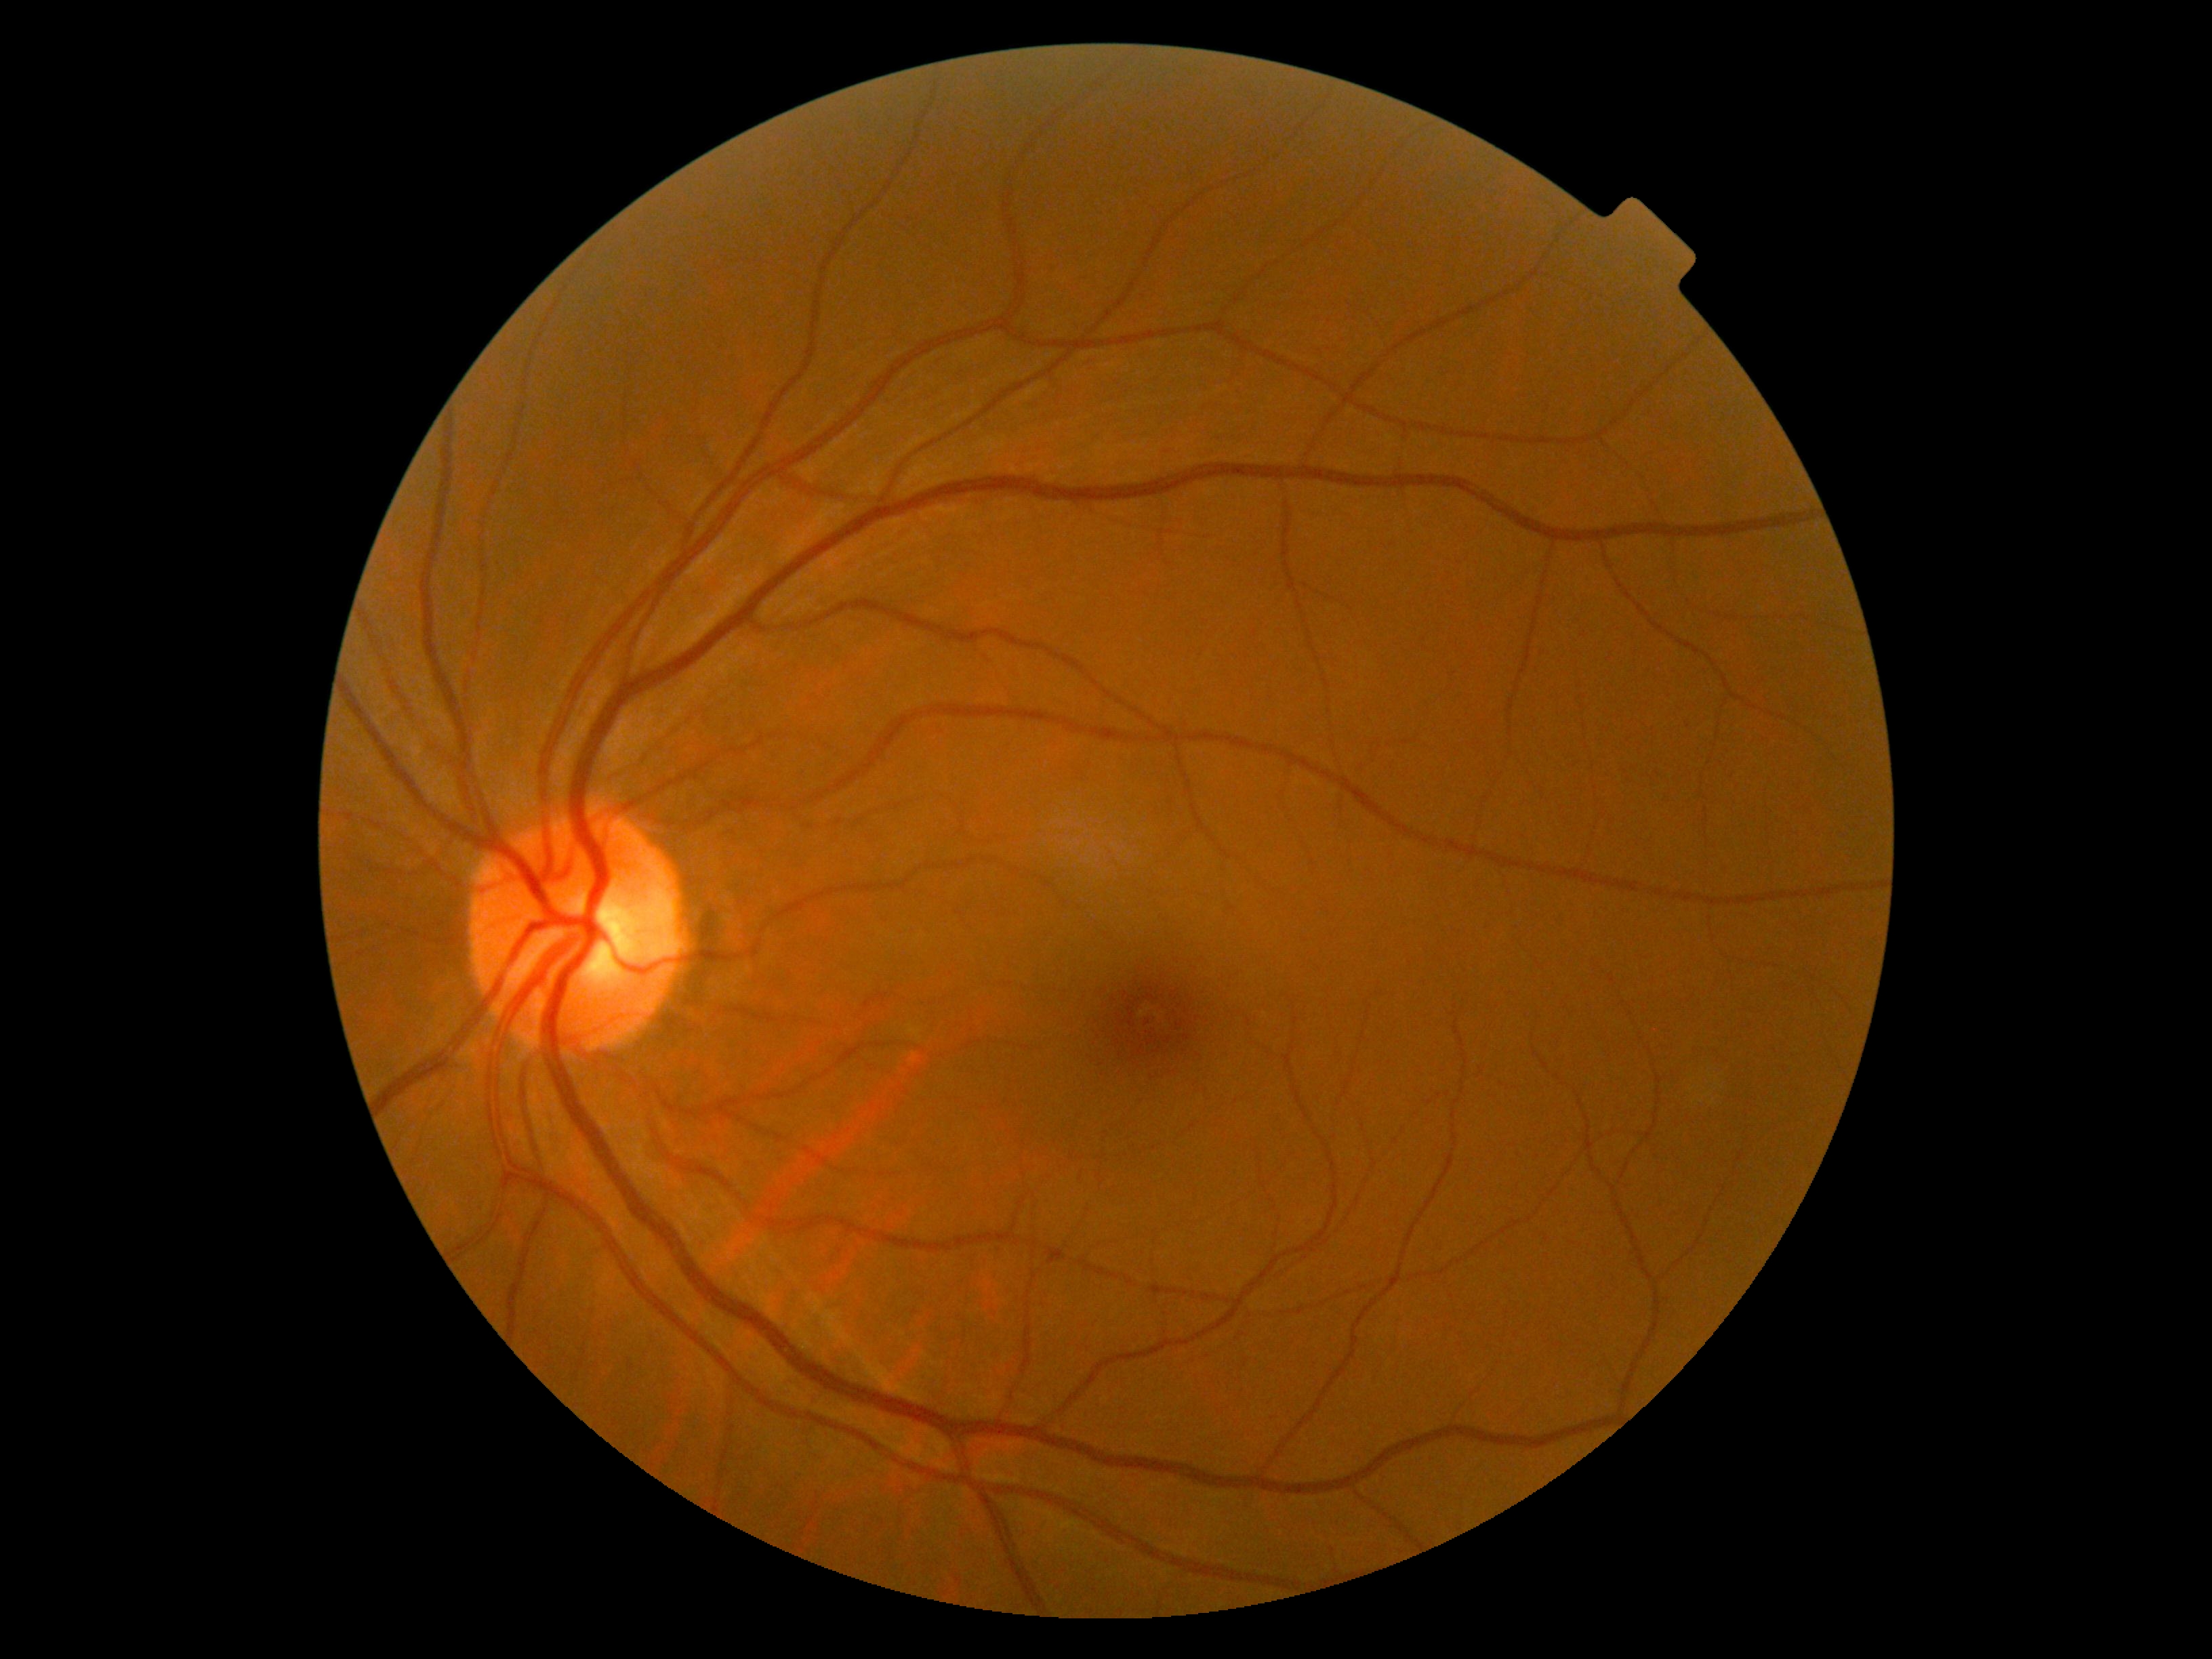 Retinopathy grade: 0.